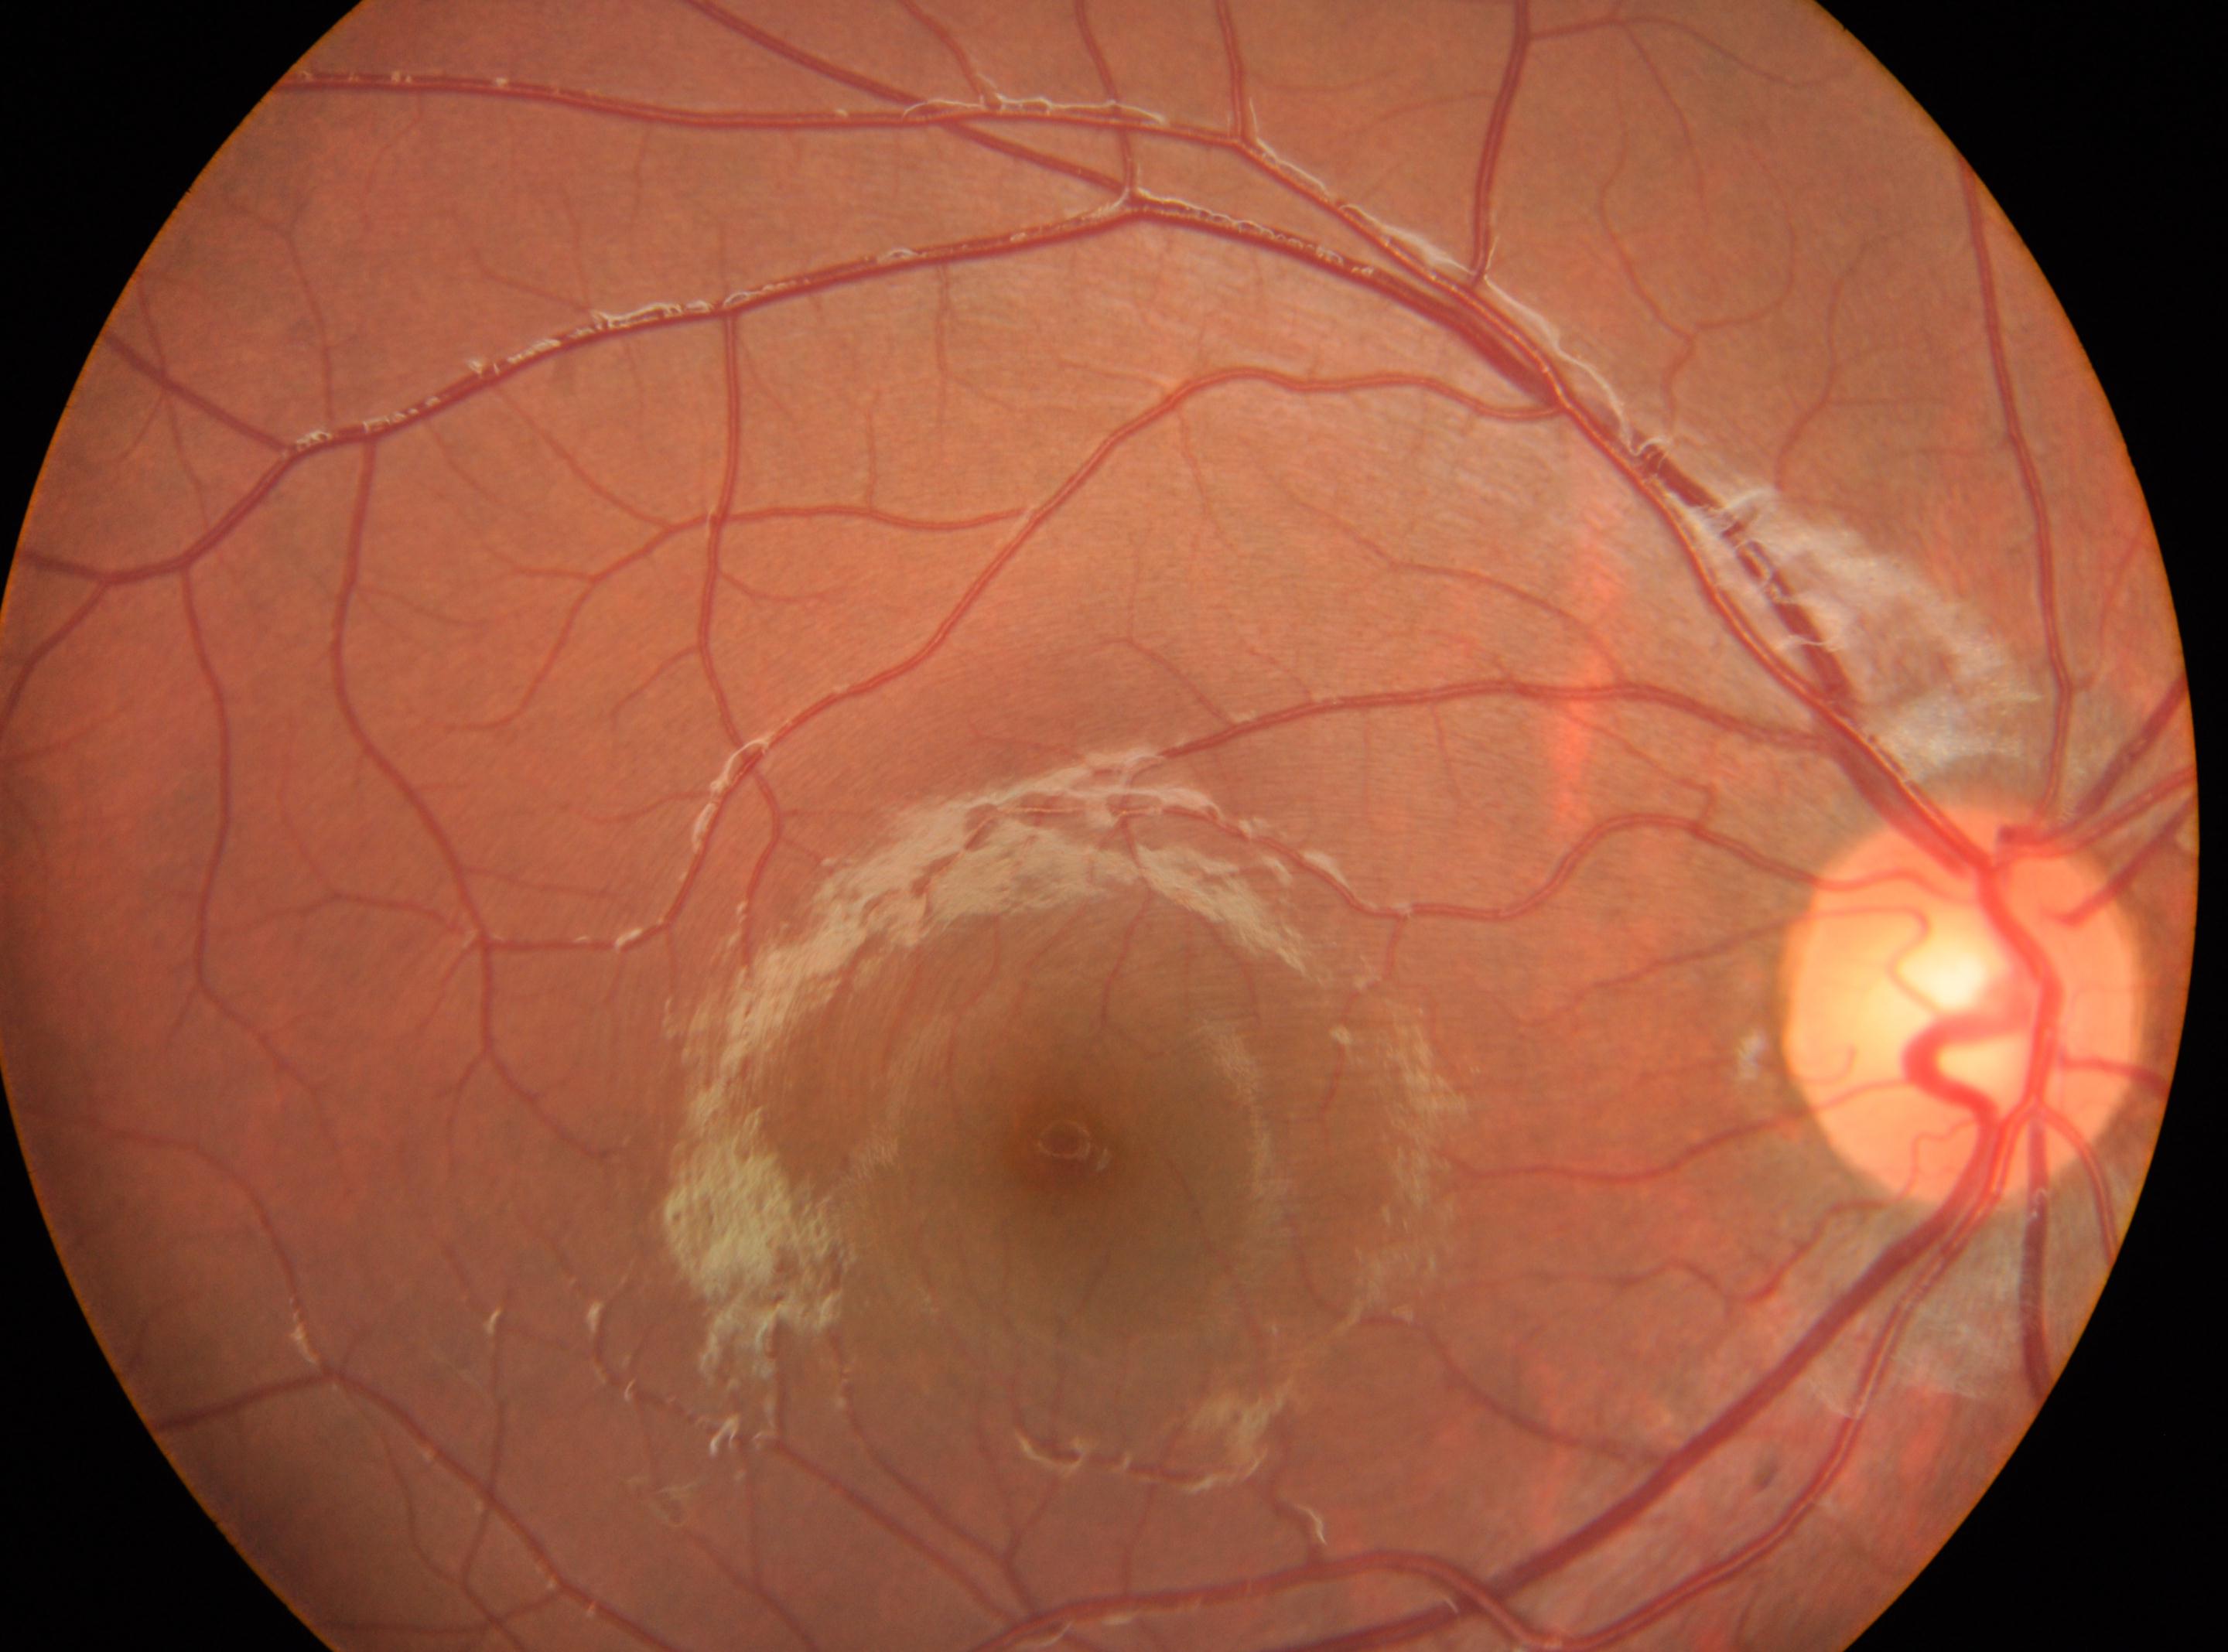 Diabetic retinopathy grade: no apparent retinopathy (0) — no visible signs of diabetic retinopathy.
Fovea center: (1078,1154).
No apparent diabetic retinopathy.
The image shows the right eye.
Disc center: (1962,1002).